Captured without pupil dilation.
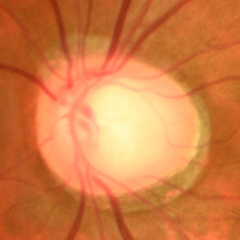
Demonstrates early glaucomatous optic neuropathy.